848x848px — 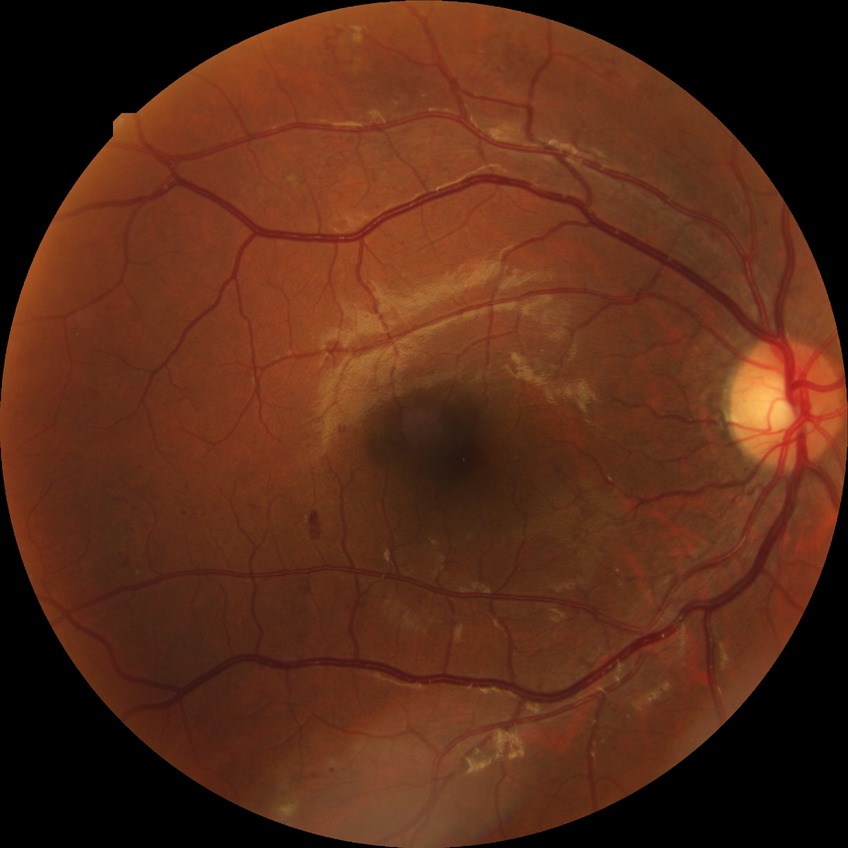 Modified Davis grading is proliferative diabetic retinopathy.